FOV: 45 degrees. 848x848. Fundus photo:
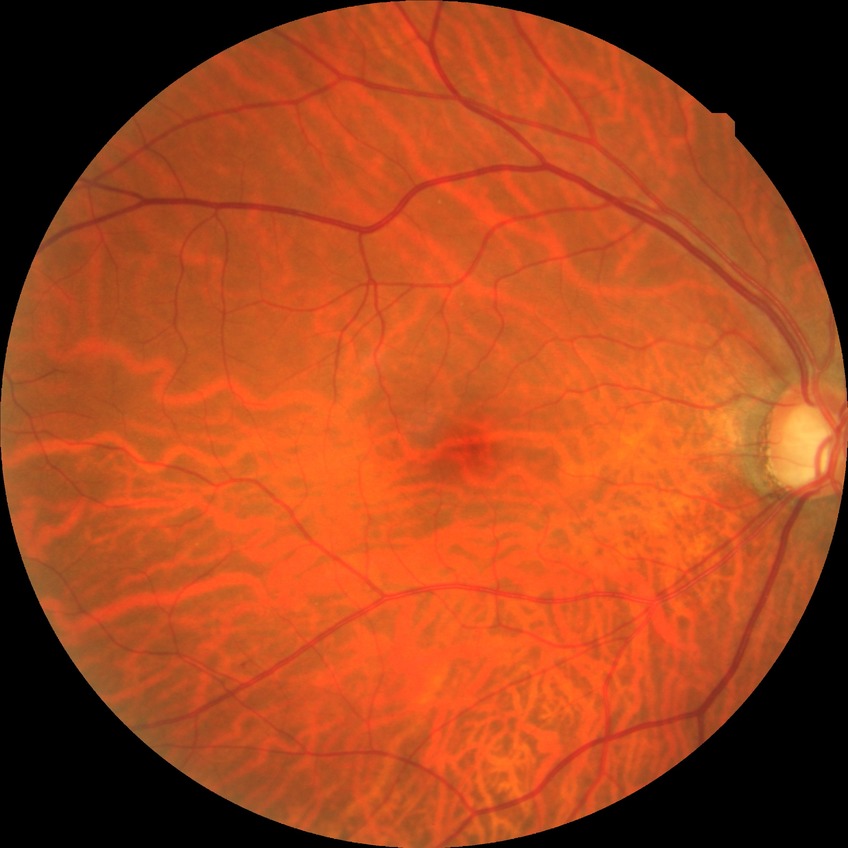 Diabetic retinopathy (DR) is no diabetic retinopathy (NDR).